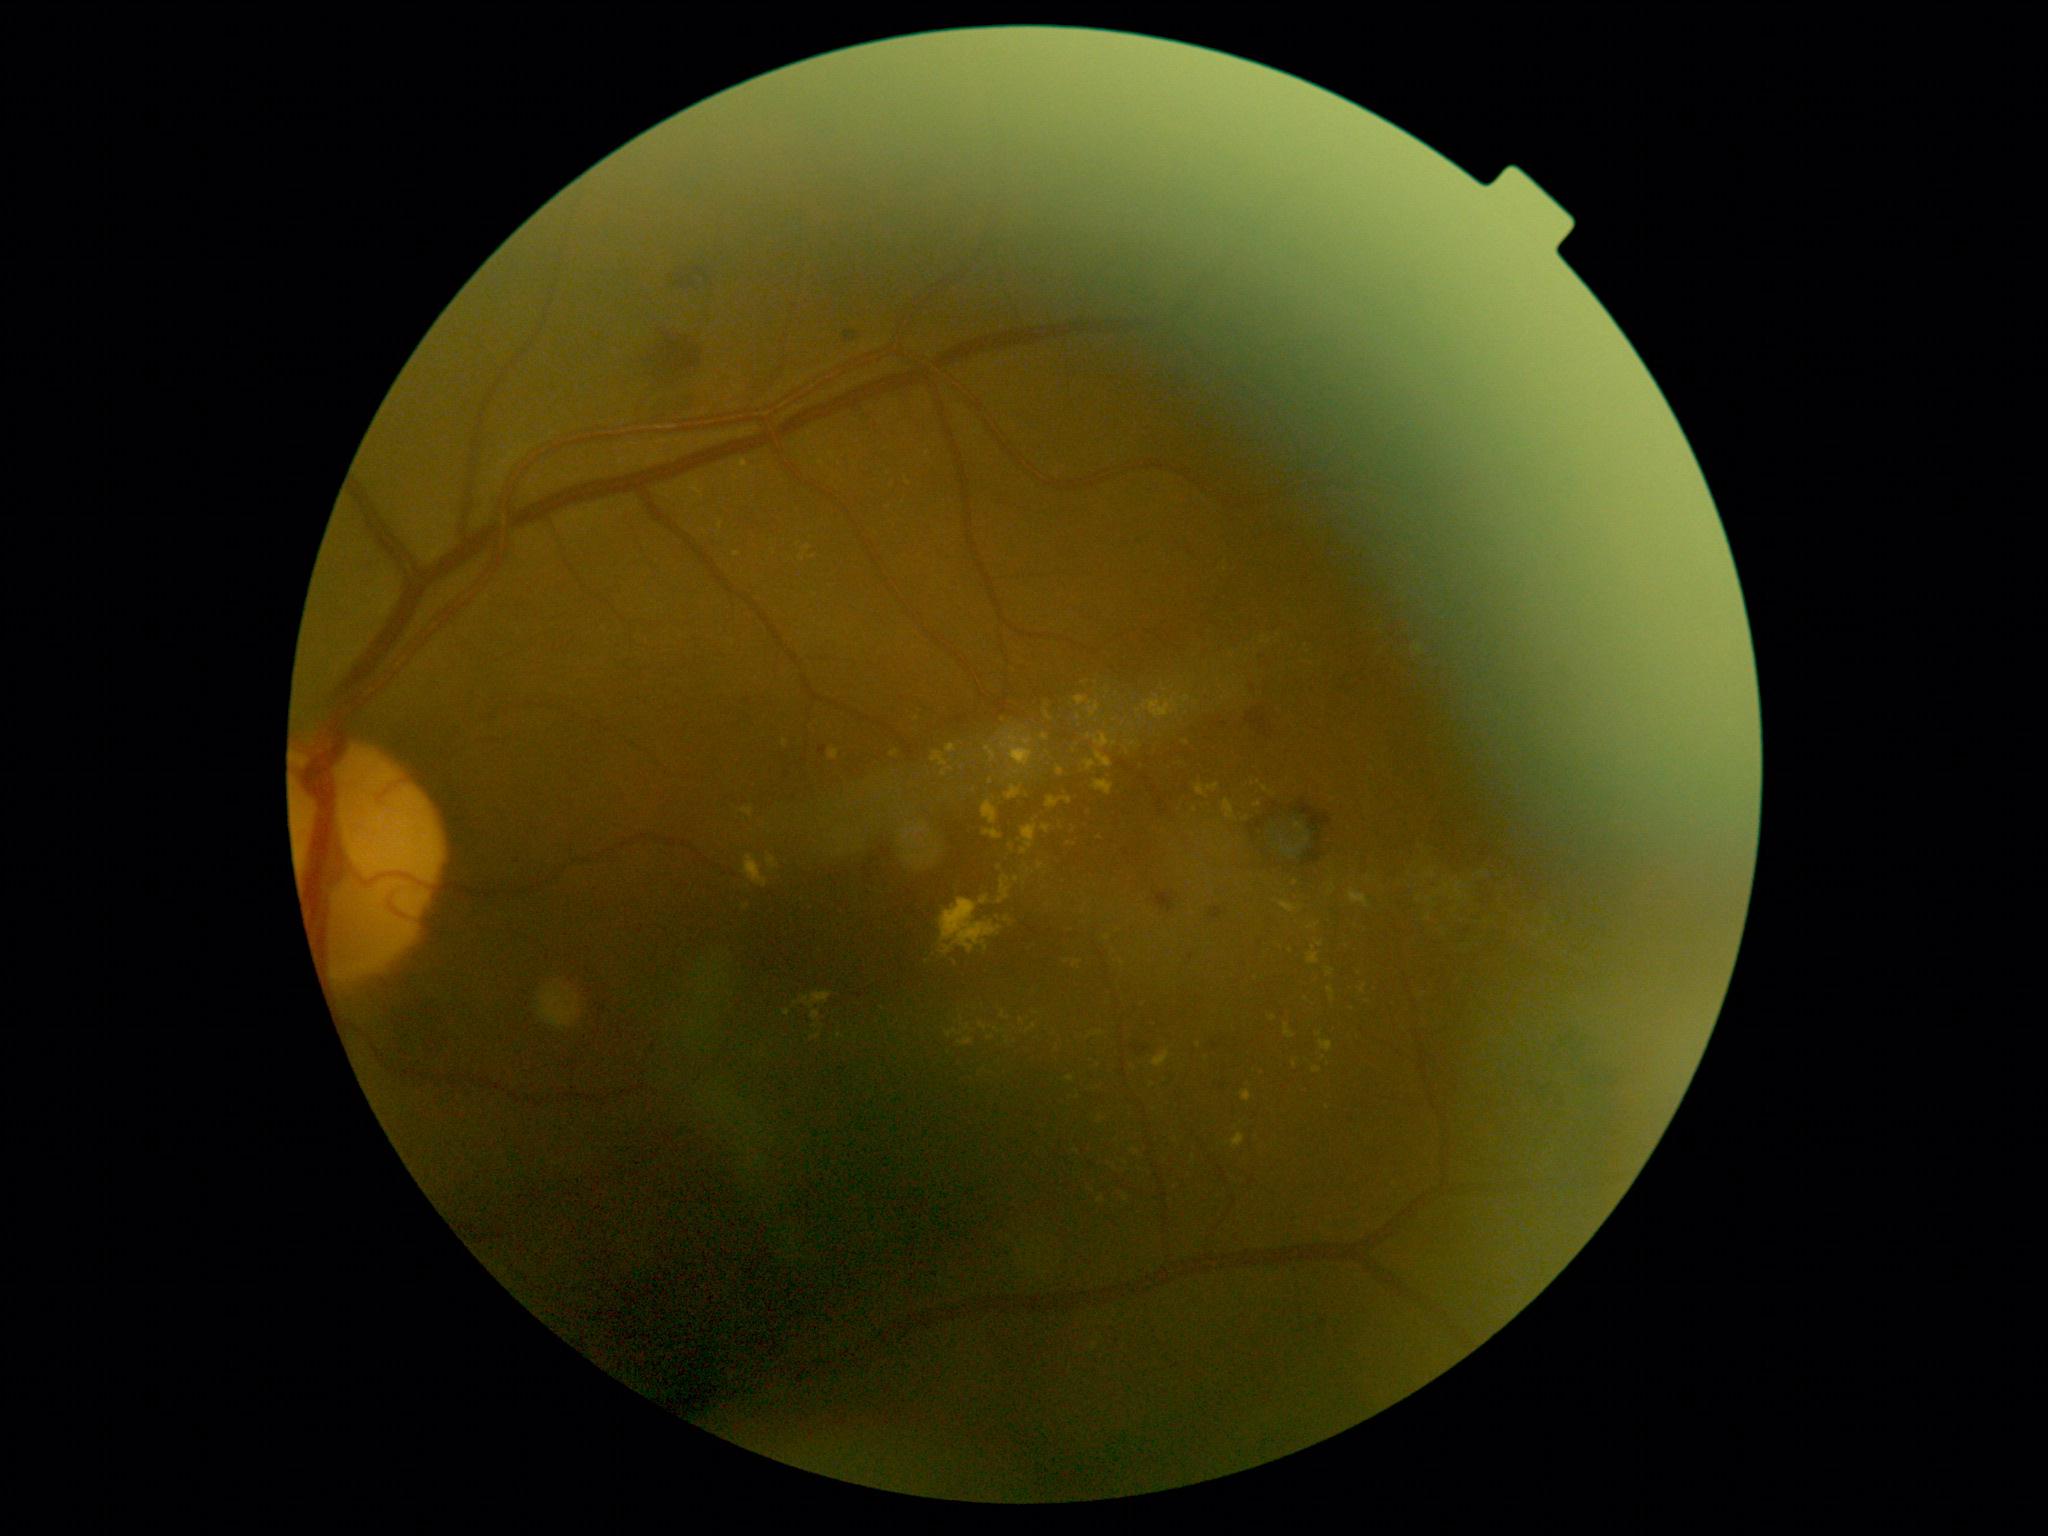
{"partial":true,"dr_grade":2,"lesions":{"ex":[[1096,752,1113,769],[1027,1024,1037,1033],[1426,871,1435,879],[1315,942,1323,948],[1232,1134,1245,1149],[1428,898,1438,908],[801,992,832,1010],[1181,695,1192,709],[718,520,722,530],[1329,885,1335,895]],"ex_small_approx":[[1139,712],[1075,844],[839,1037],[1319,1035],[1263,641],[1100,1120],[1307,840]]}}